Fundus photo, 1920 x 1088 pixels, FOV: 45 degrees.
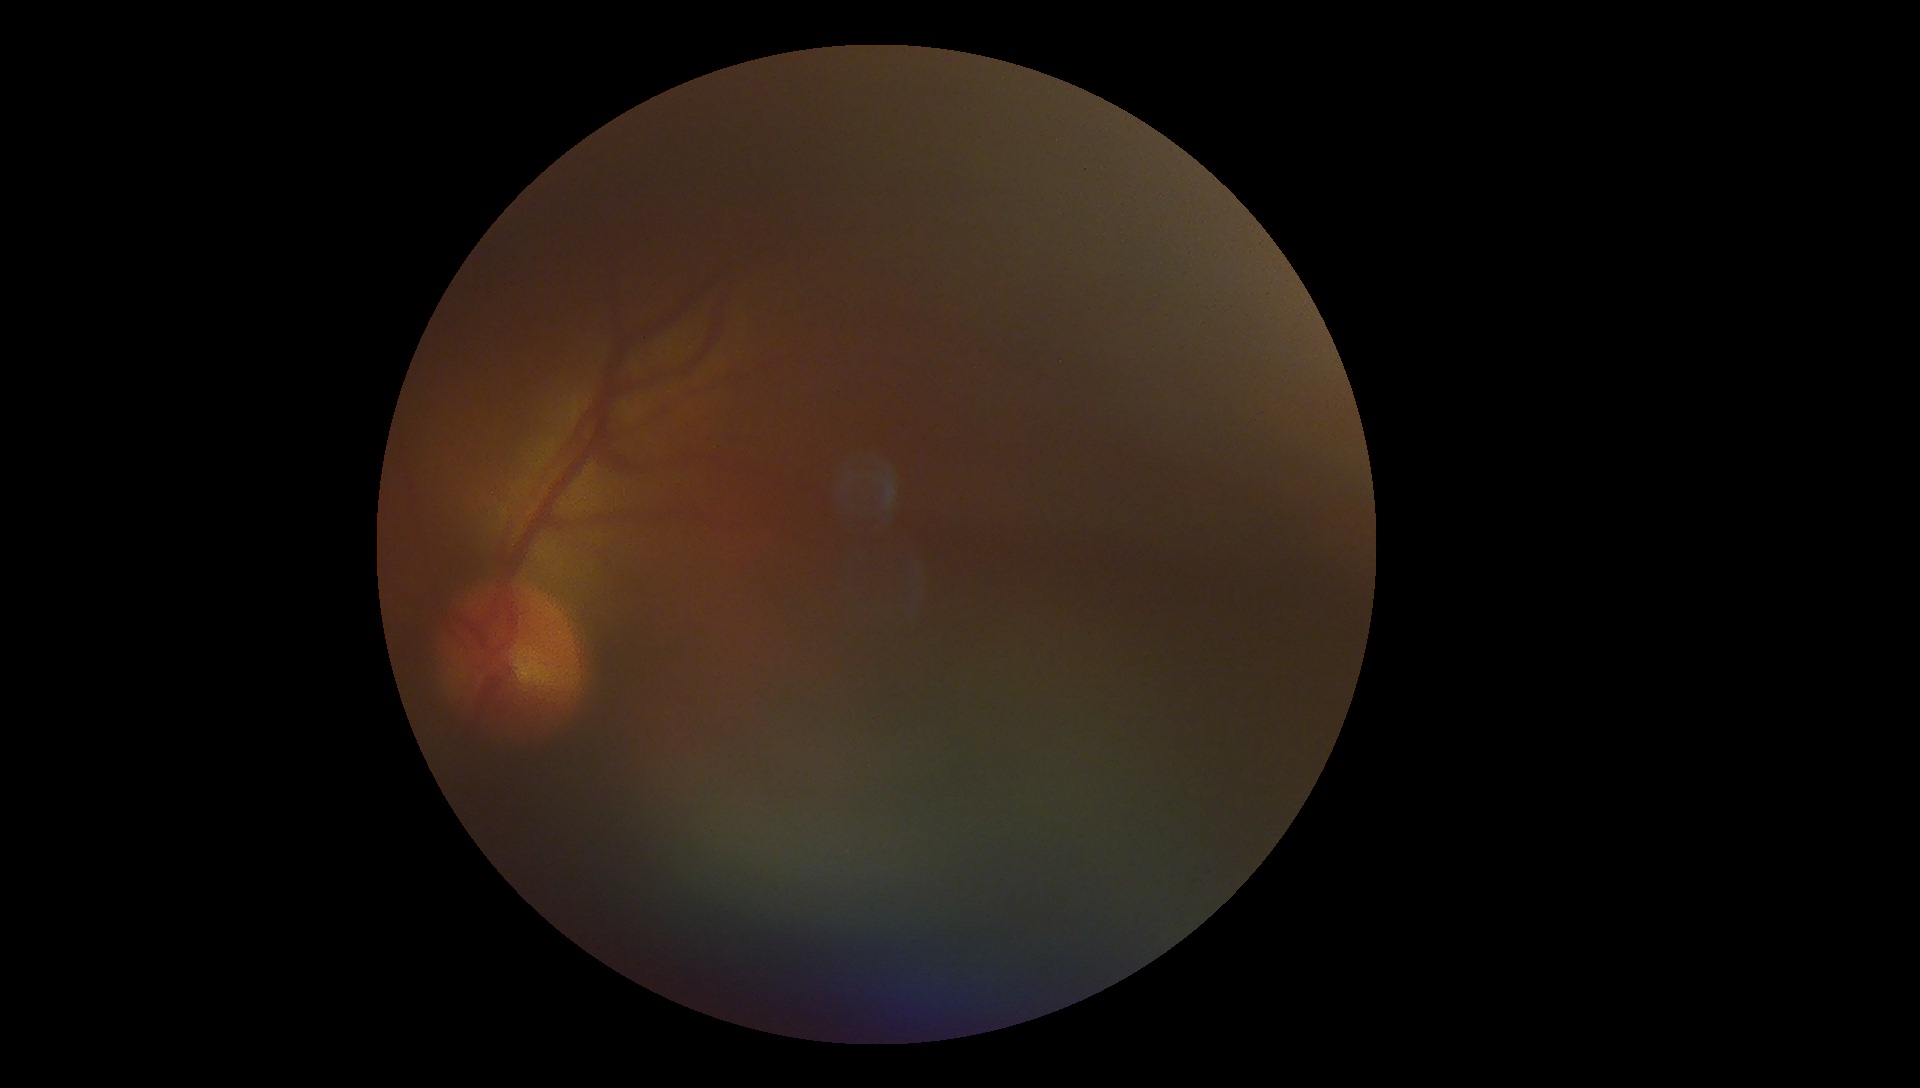 DR stage is ungradable due to poor image quality.